45° field of view — 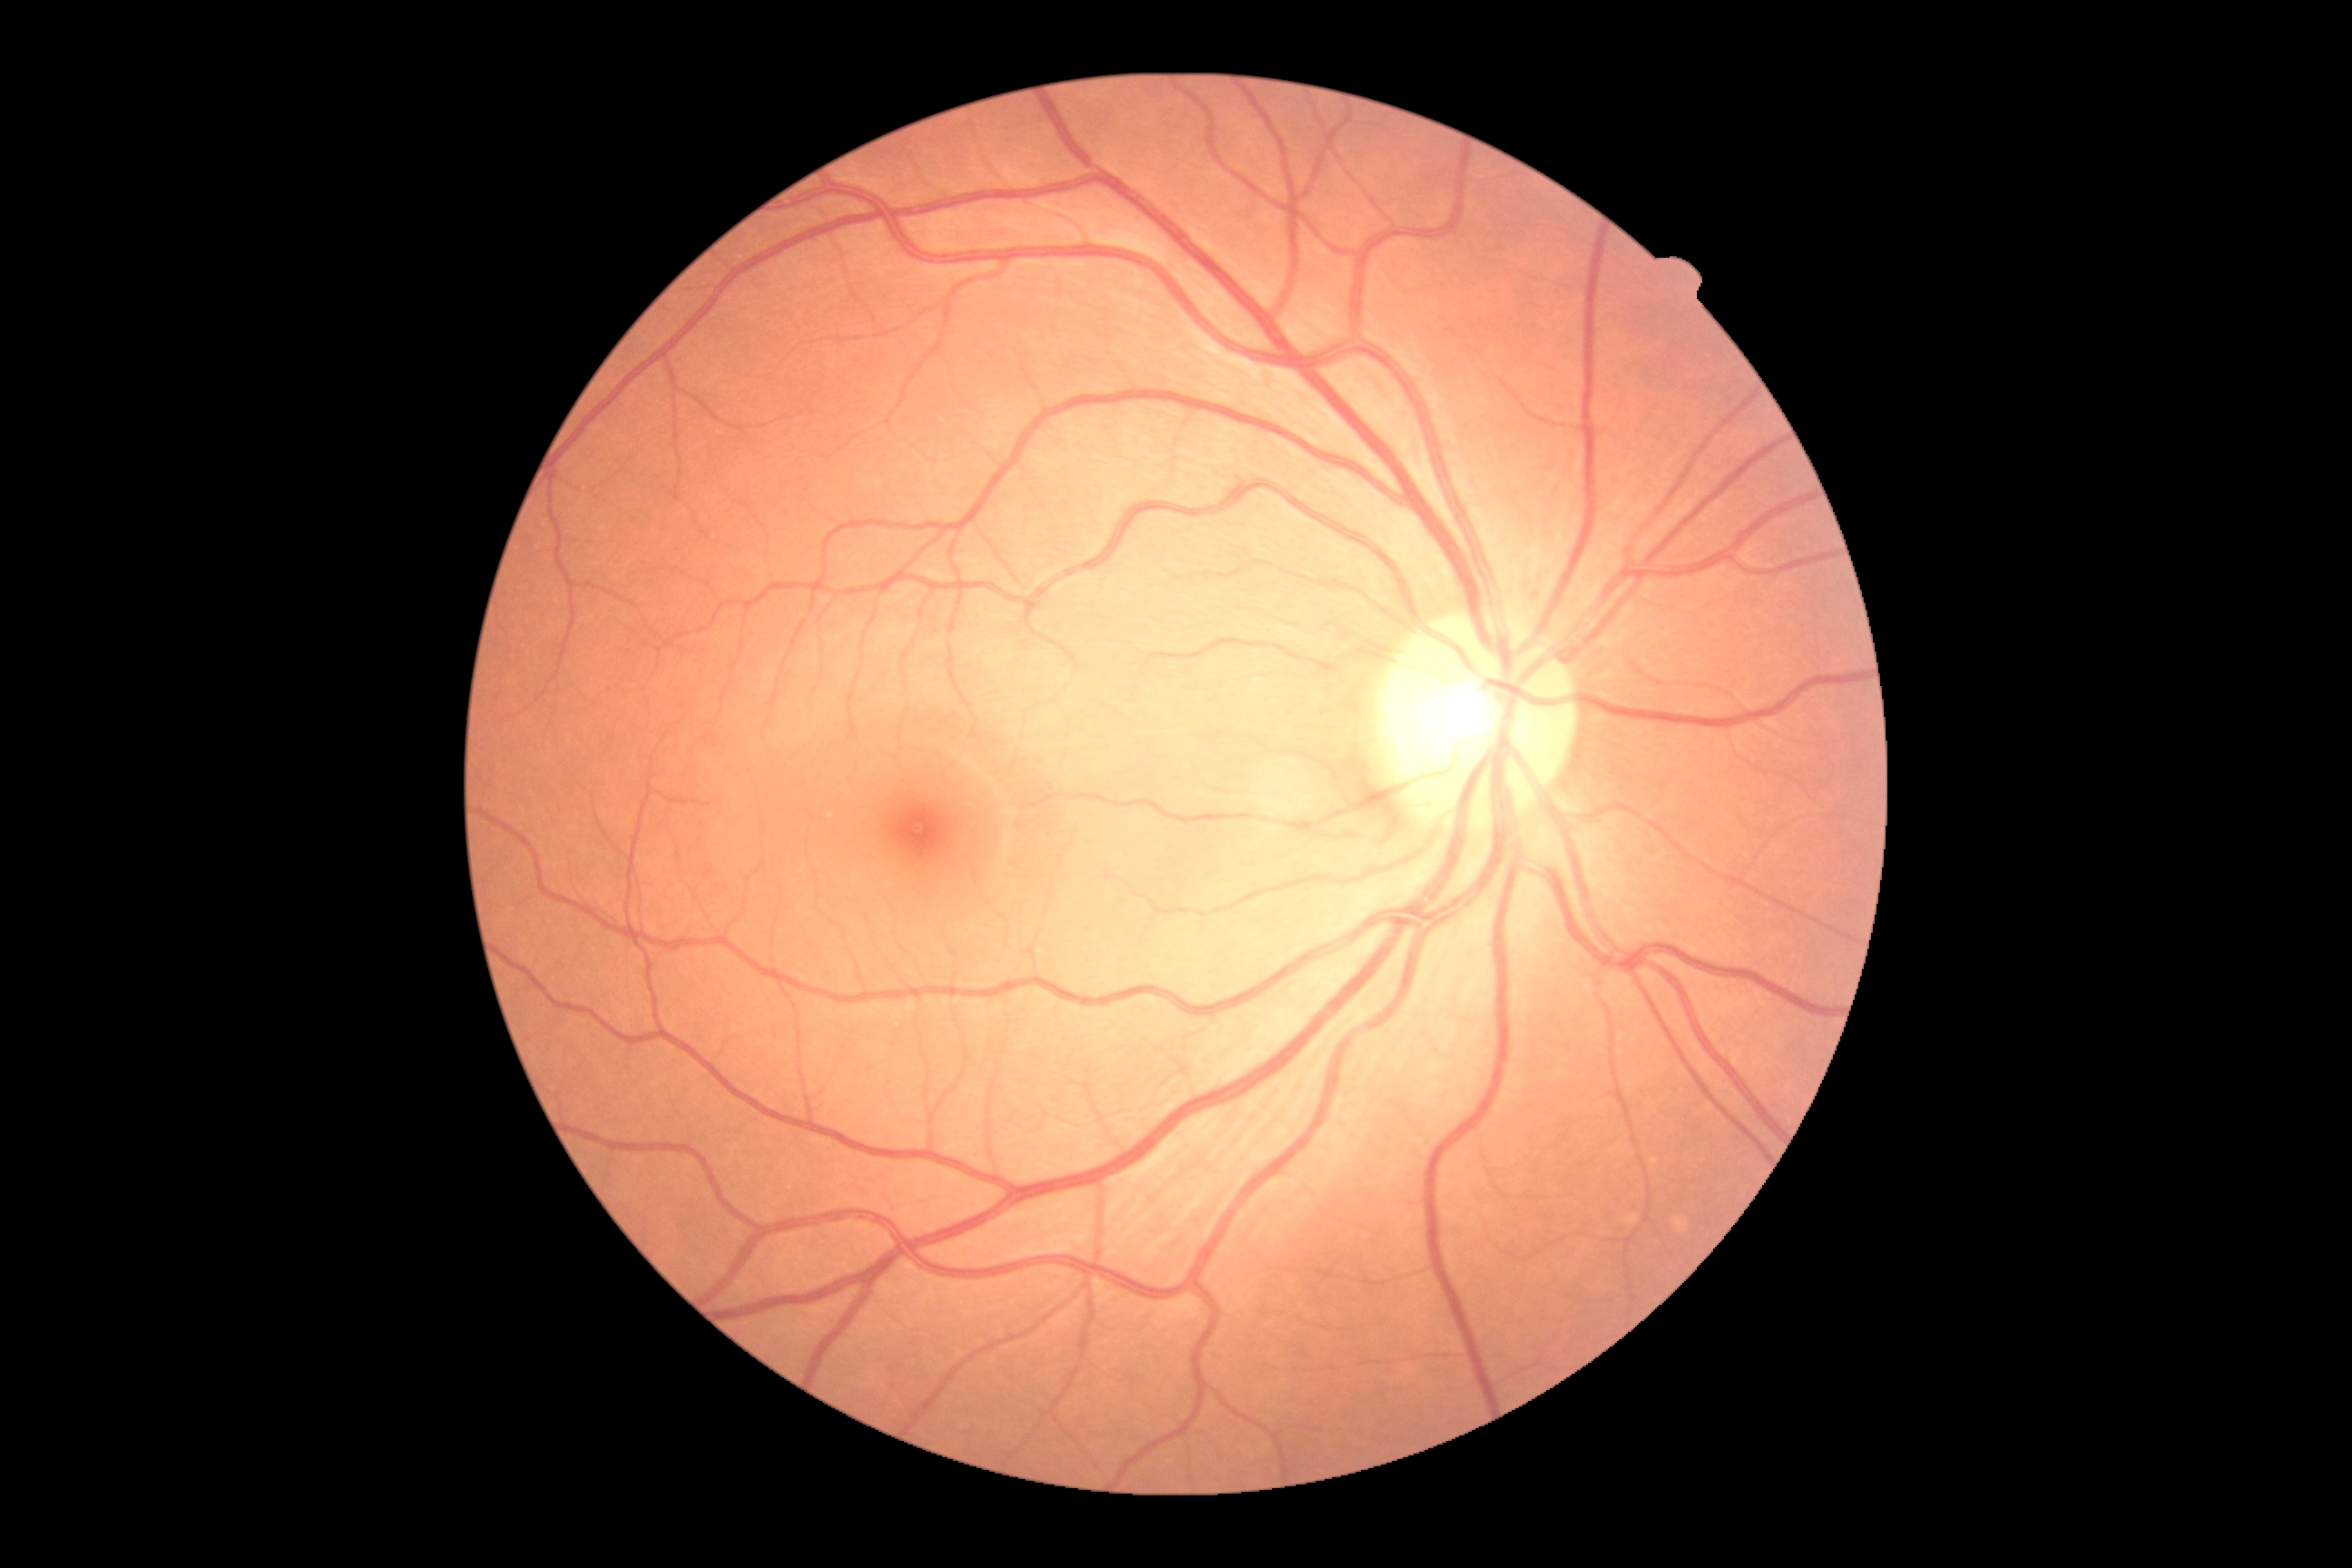

{"dr_grade": "grade 0"}